Retinal fundus photograph: 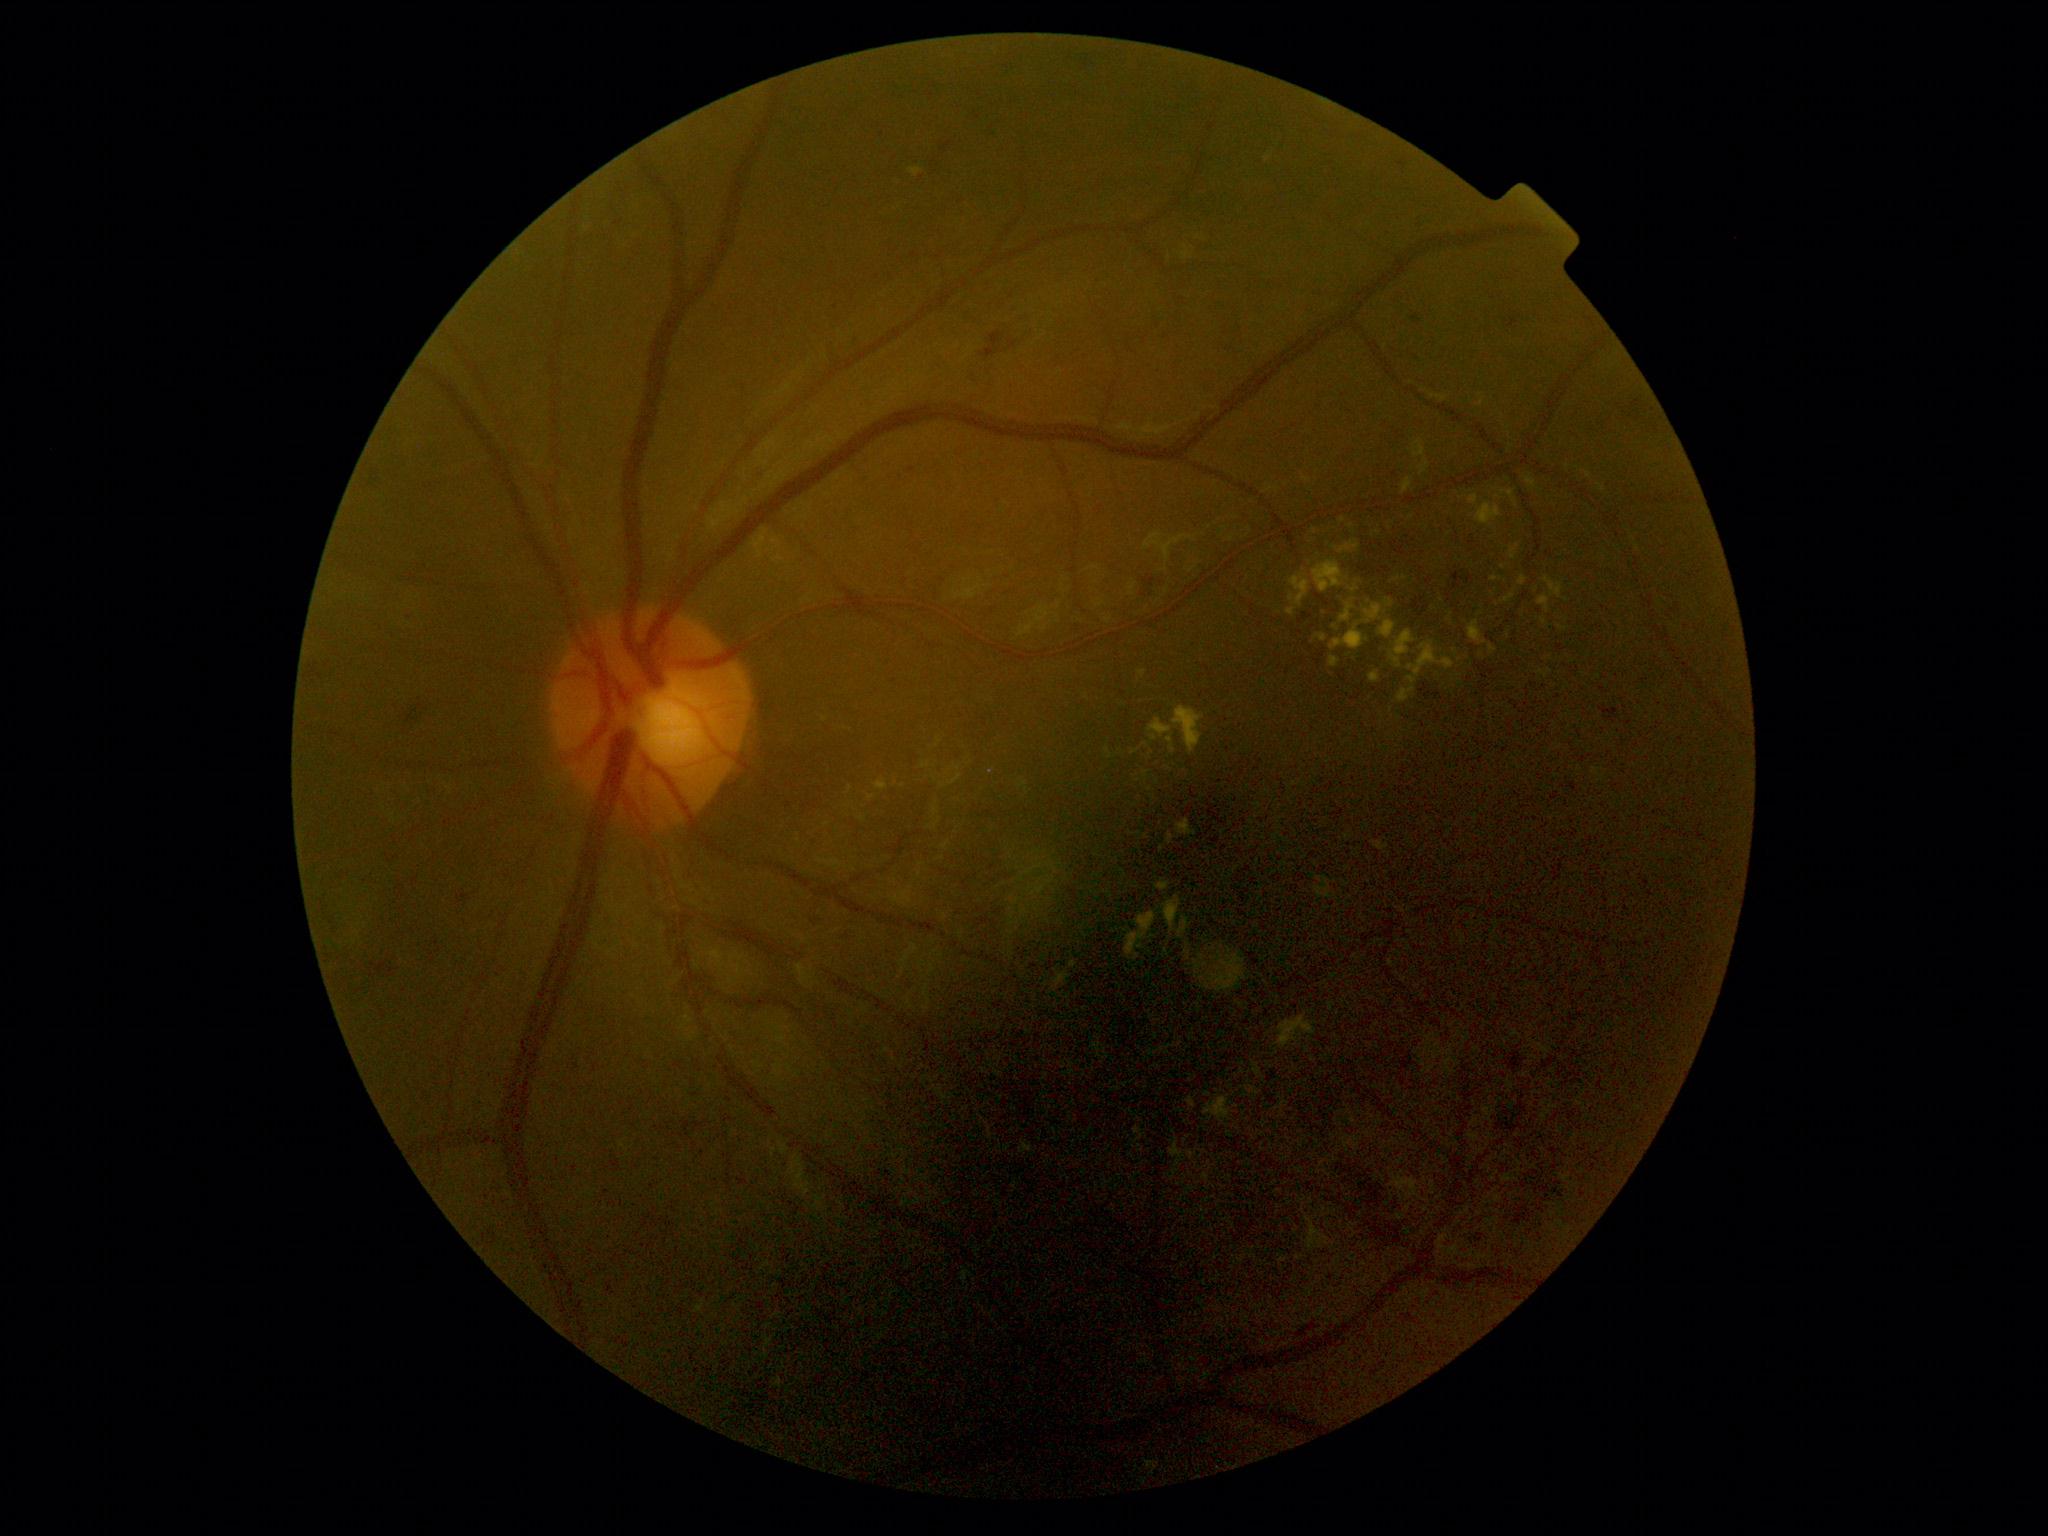
Diabetic retinopathy severity: grade 2 (moderate NPDR)
Selected lesions:
hemorrhages (more not shown): <box>941,142,953,154</box>; <box>404,704,434,728</box>; <box>1420,606,1430,618</box>; <box>1466,576,1474,585</box>; <box>1517,1168,1580,1207</box>; <box>1629,401,1642,411</box>; <box>974,113,981,121</box>; <box>1569,783,1579,794</box>; <box>1055,348,1093,369</box>; <box>1453,573,1465,590</box>; <box>979,326,1035,363</box>; <box>479,1230,504,1253</box>; <box>1421,684,1441,701</box>; <box>971,371,986,389</box>
Small hemorrhages approximately at (x=942, y=580); (x=1638, y=420); (x=1631, y=417); (x=1416, y=357); (x=921, y=178)
hard exudates (more not shown): <box>1185,950,1191,961</box>; <box>1476,503,1503,527</box>; <box>1389,1172,1424,1201</box>; <box>1172,707,1205,756</box>; <box>1379,620,1397,639</box>; <box>1167,735,1177,754</box>; <box>1105,748,1112,760</box>; <box>1131,750,1139,756</box>; <box>1177,918,1190,939</box>; <box>1502,595,1516,603</box>; <box>1510,545,1520,560</box>
Small hard exudates approximately at (x=1152, y=753); (x=1315, y=531); (x=903, y=786); (x=1188, y=946); (x=1353, y=600); (x=1207, y=1094)